1536x1152px · 45-degree field of view: 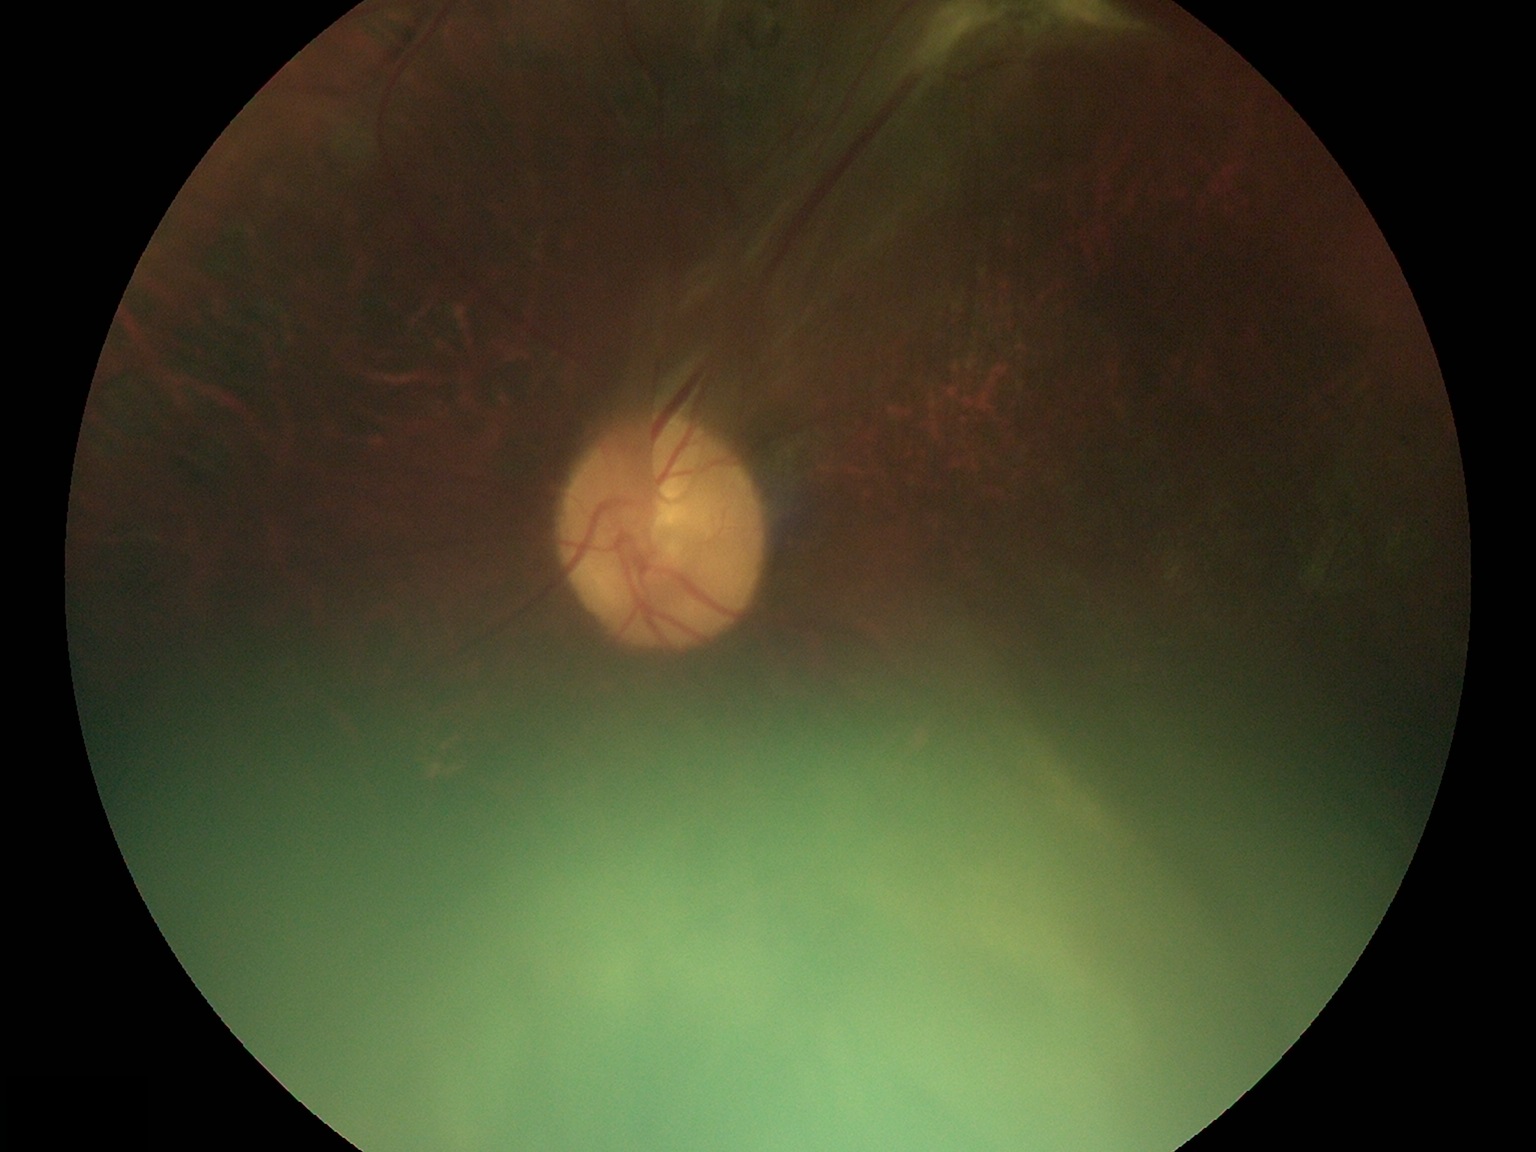 Retinopathy grade is 4.